Color fundus image. Captured after pupil dilation. FOV: 50 degrees:
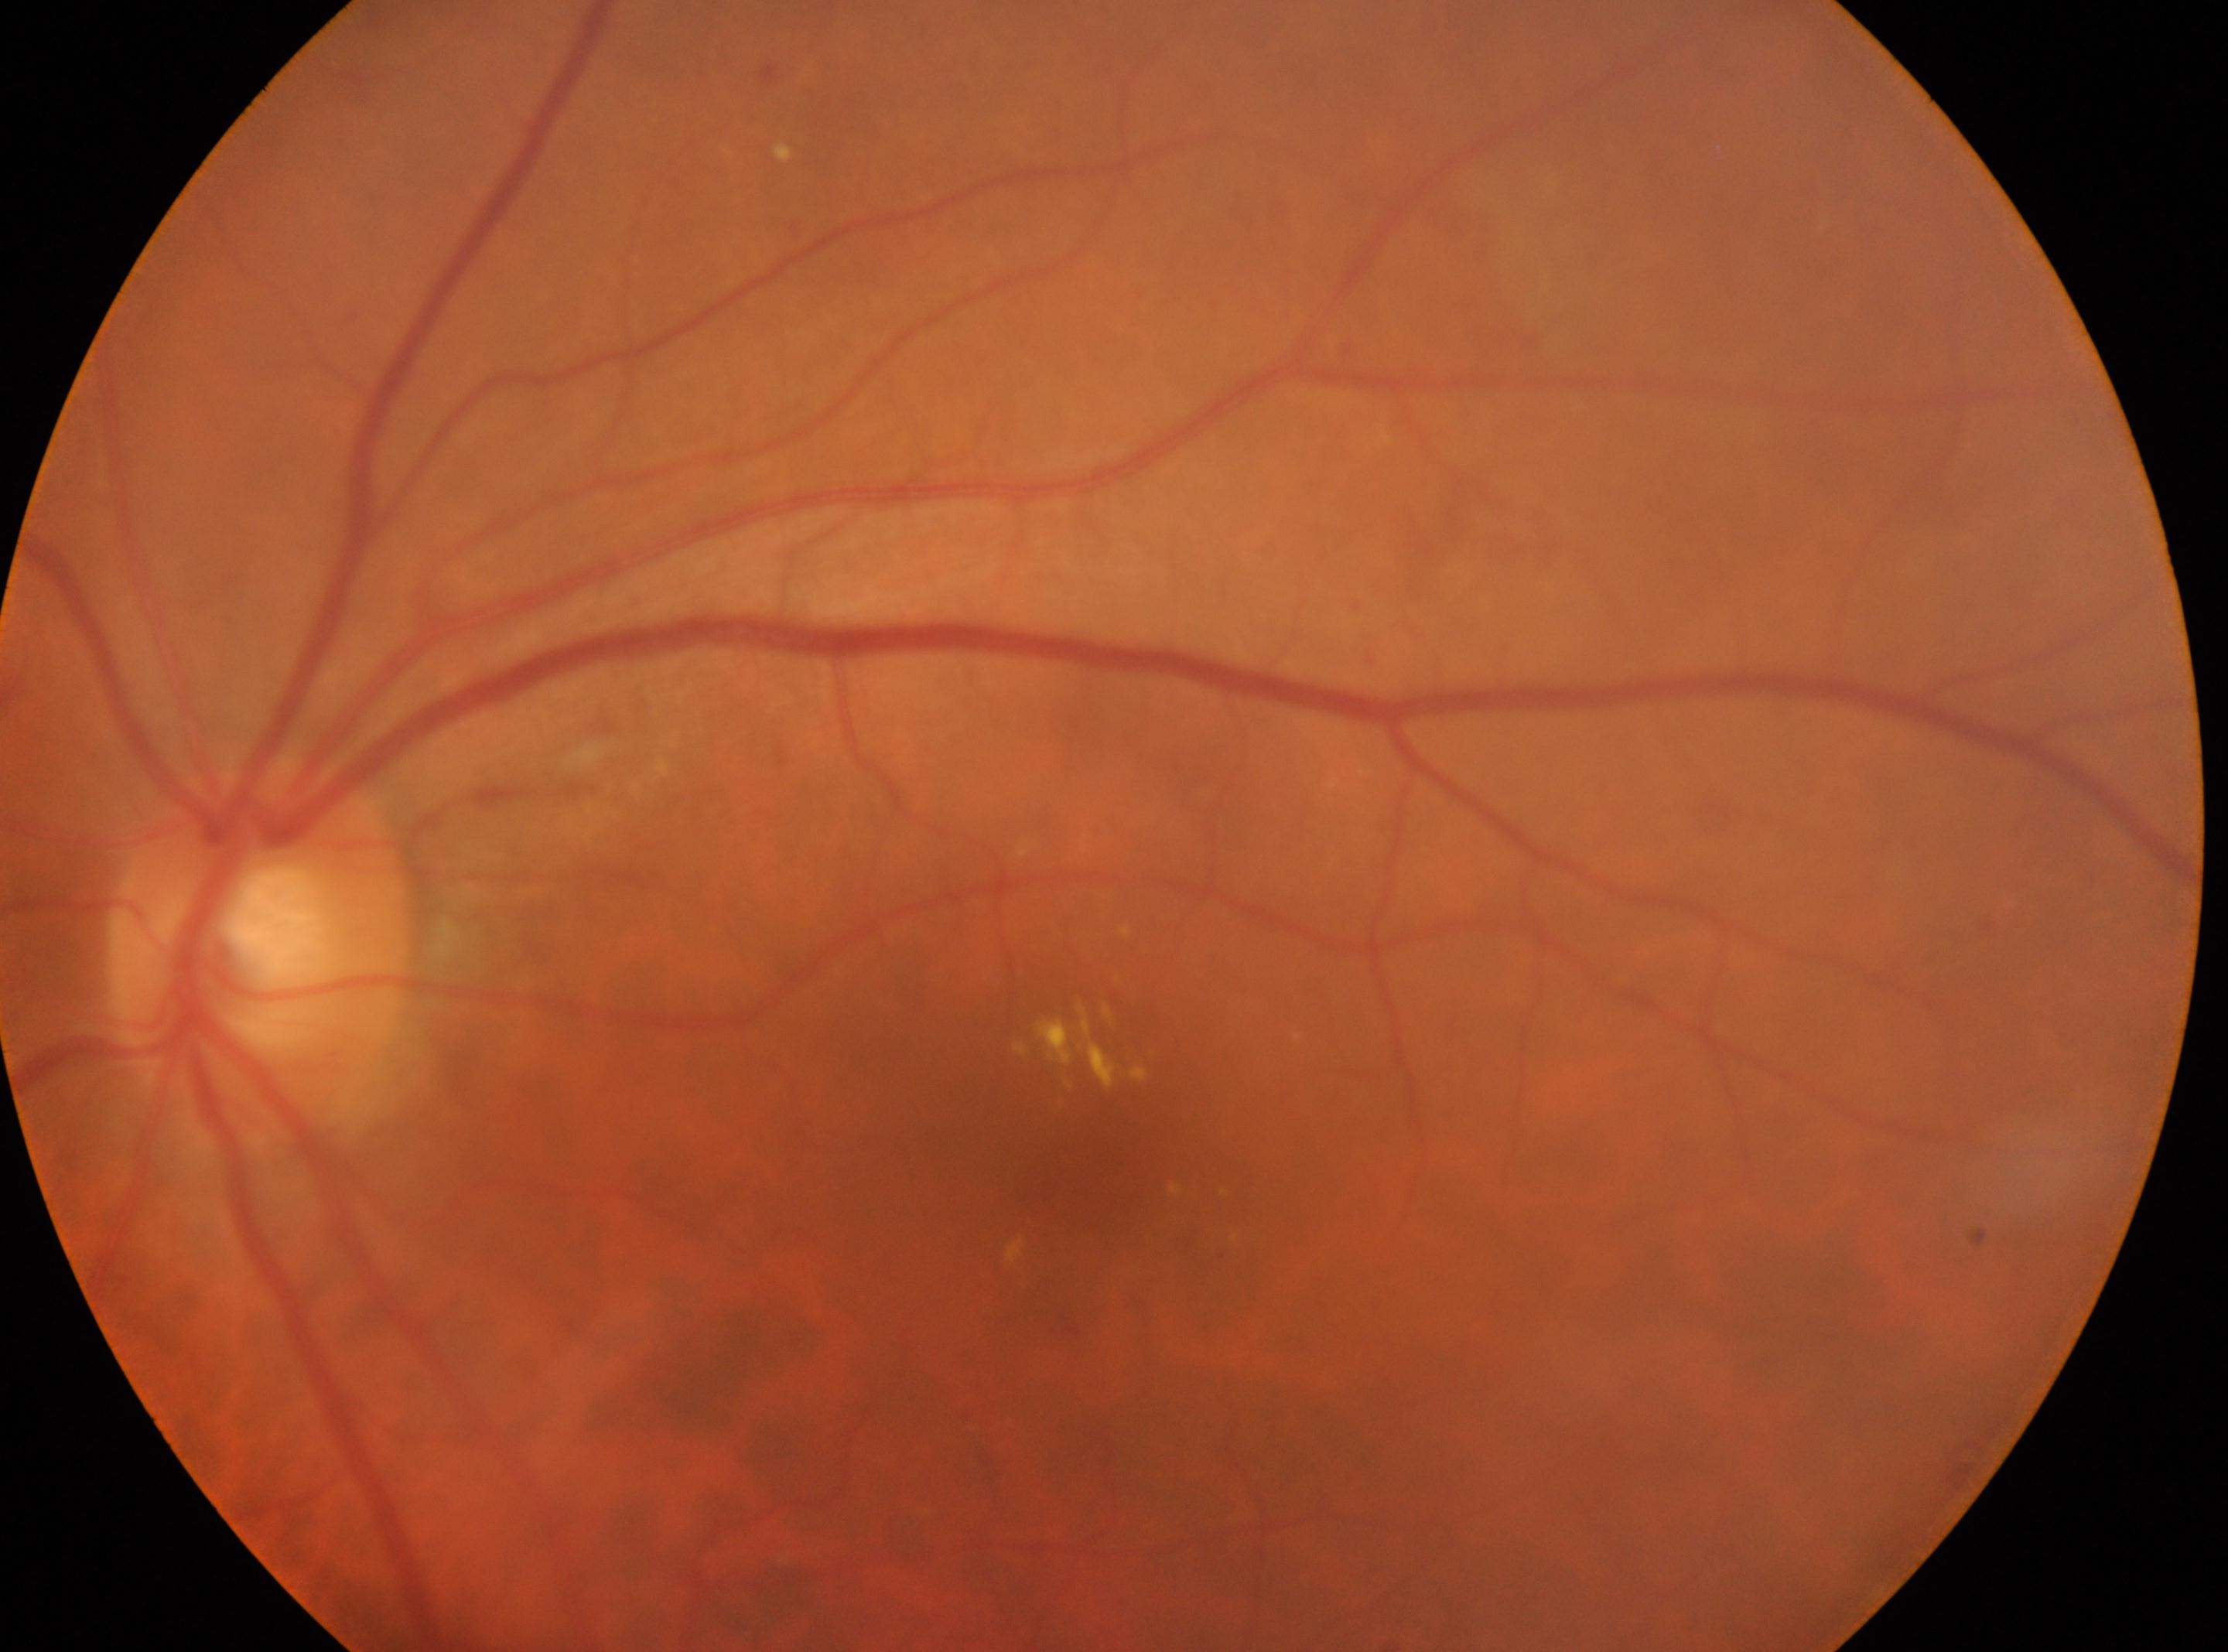
Optic disc: (257, 956). Eye: oculus sinister. The retinopathy is classified as non-proliferative diabetic retinopathy. Macular center located at (1092, 1182). Diabetic retinopathy (DR): moderate NPDR (grade 2).